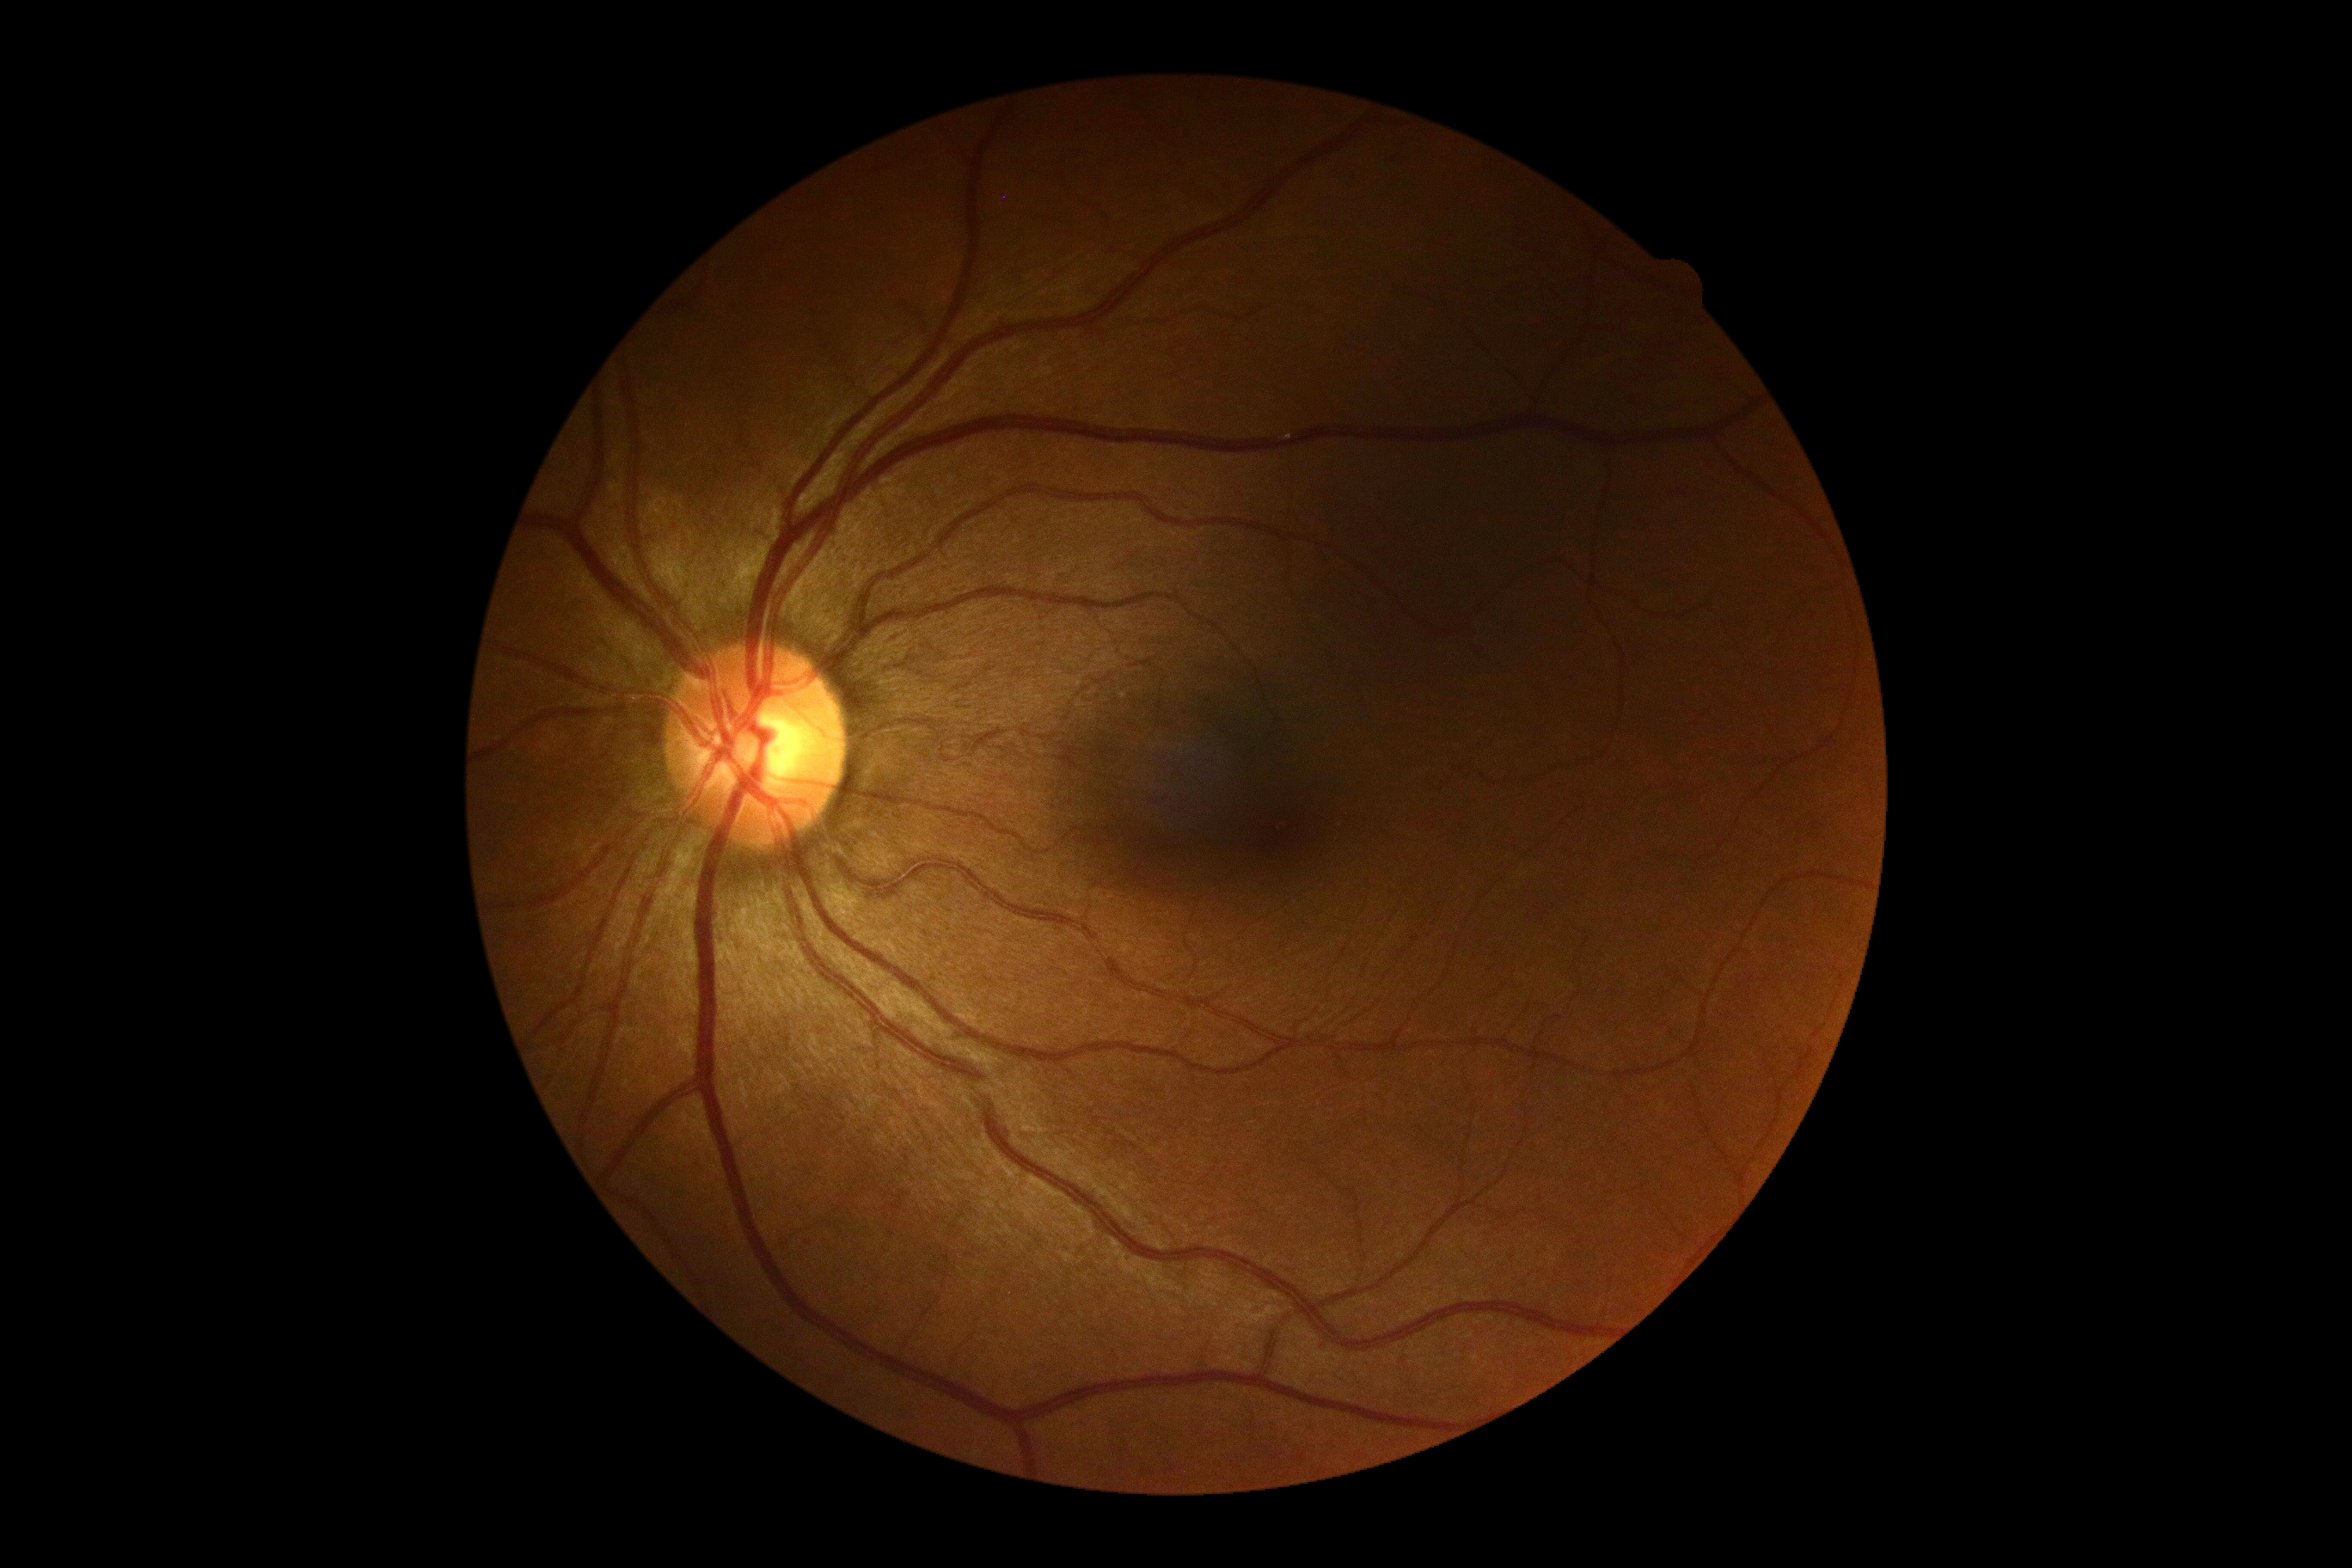
Diabetic retinopathy severity is no apparent diabetic retinopathy (grade 0) — no visible signs of diabetic retinopathy.